Posterior pole photograph. Image size 848x848. 45-degree field of view. Acquired with a NIDEK AFC-230 — 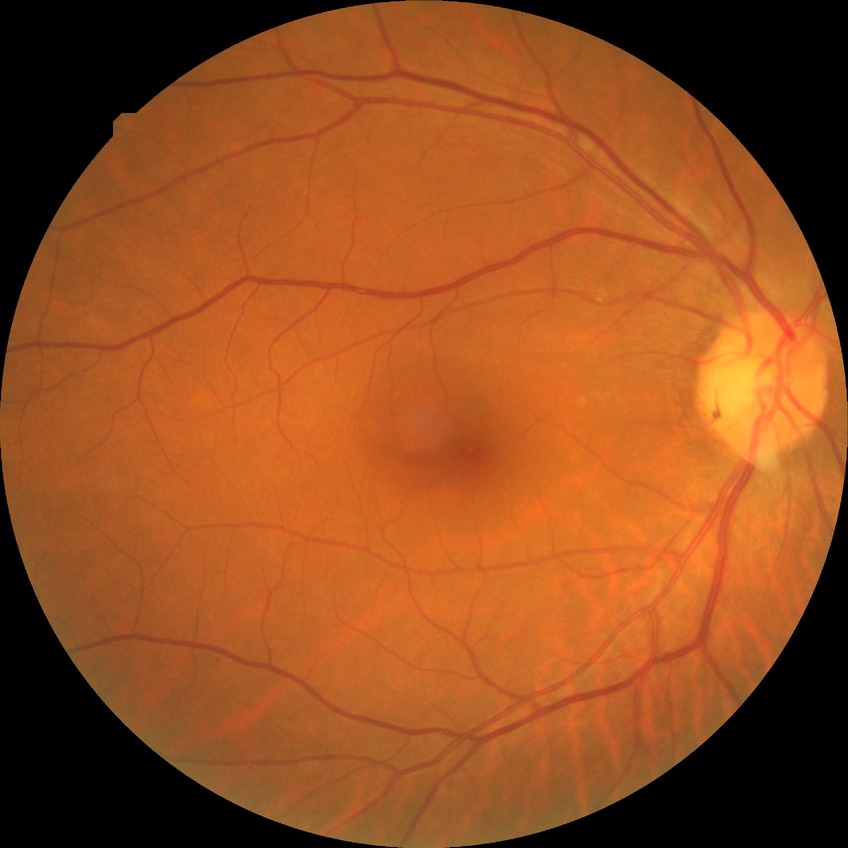 Diabetic retinopathy (DR): no diabetic retinopathy (NDR).